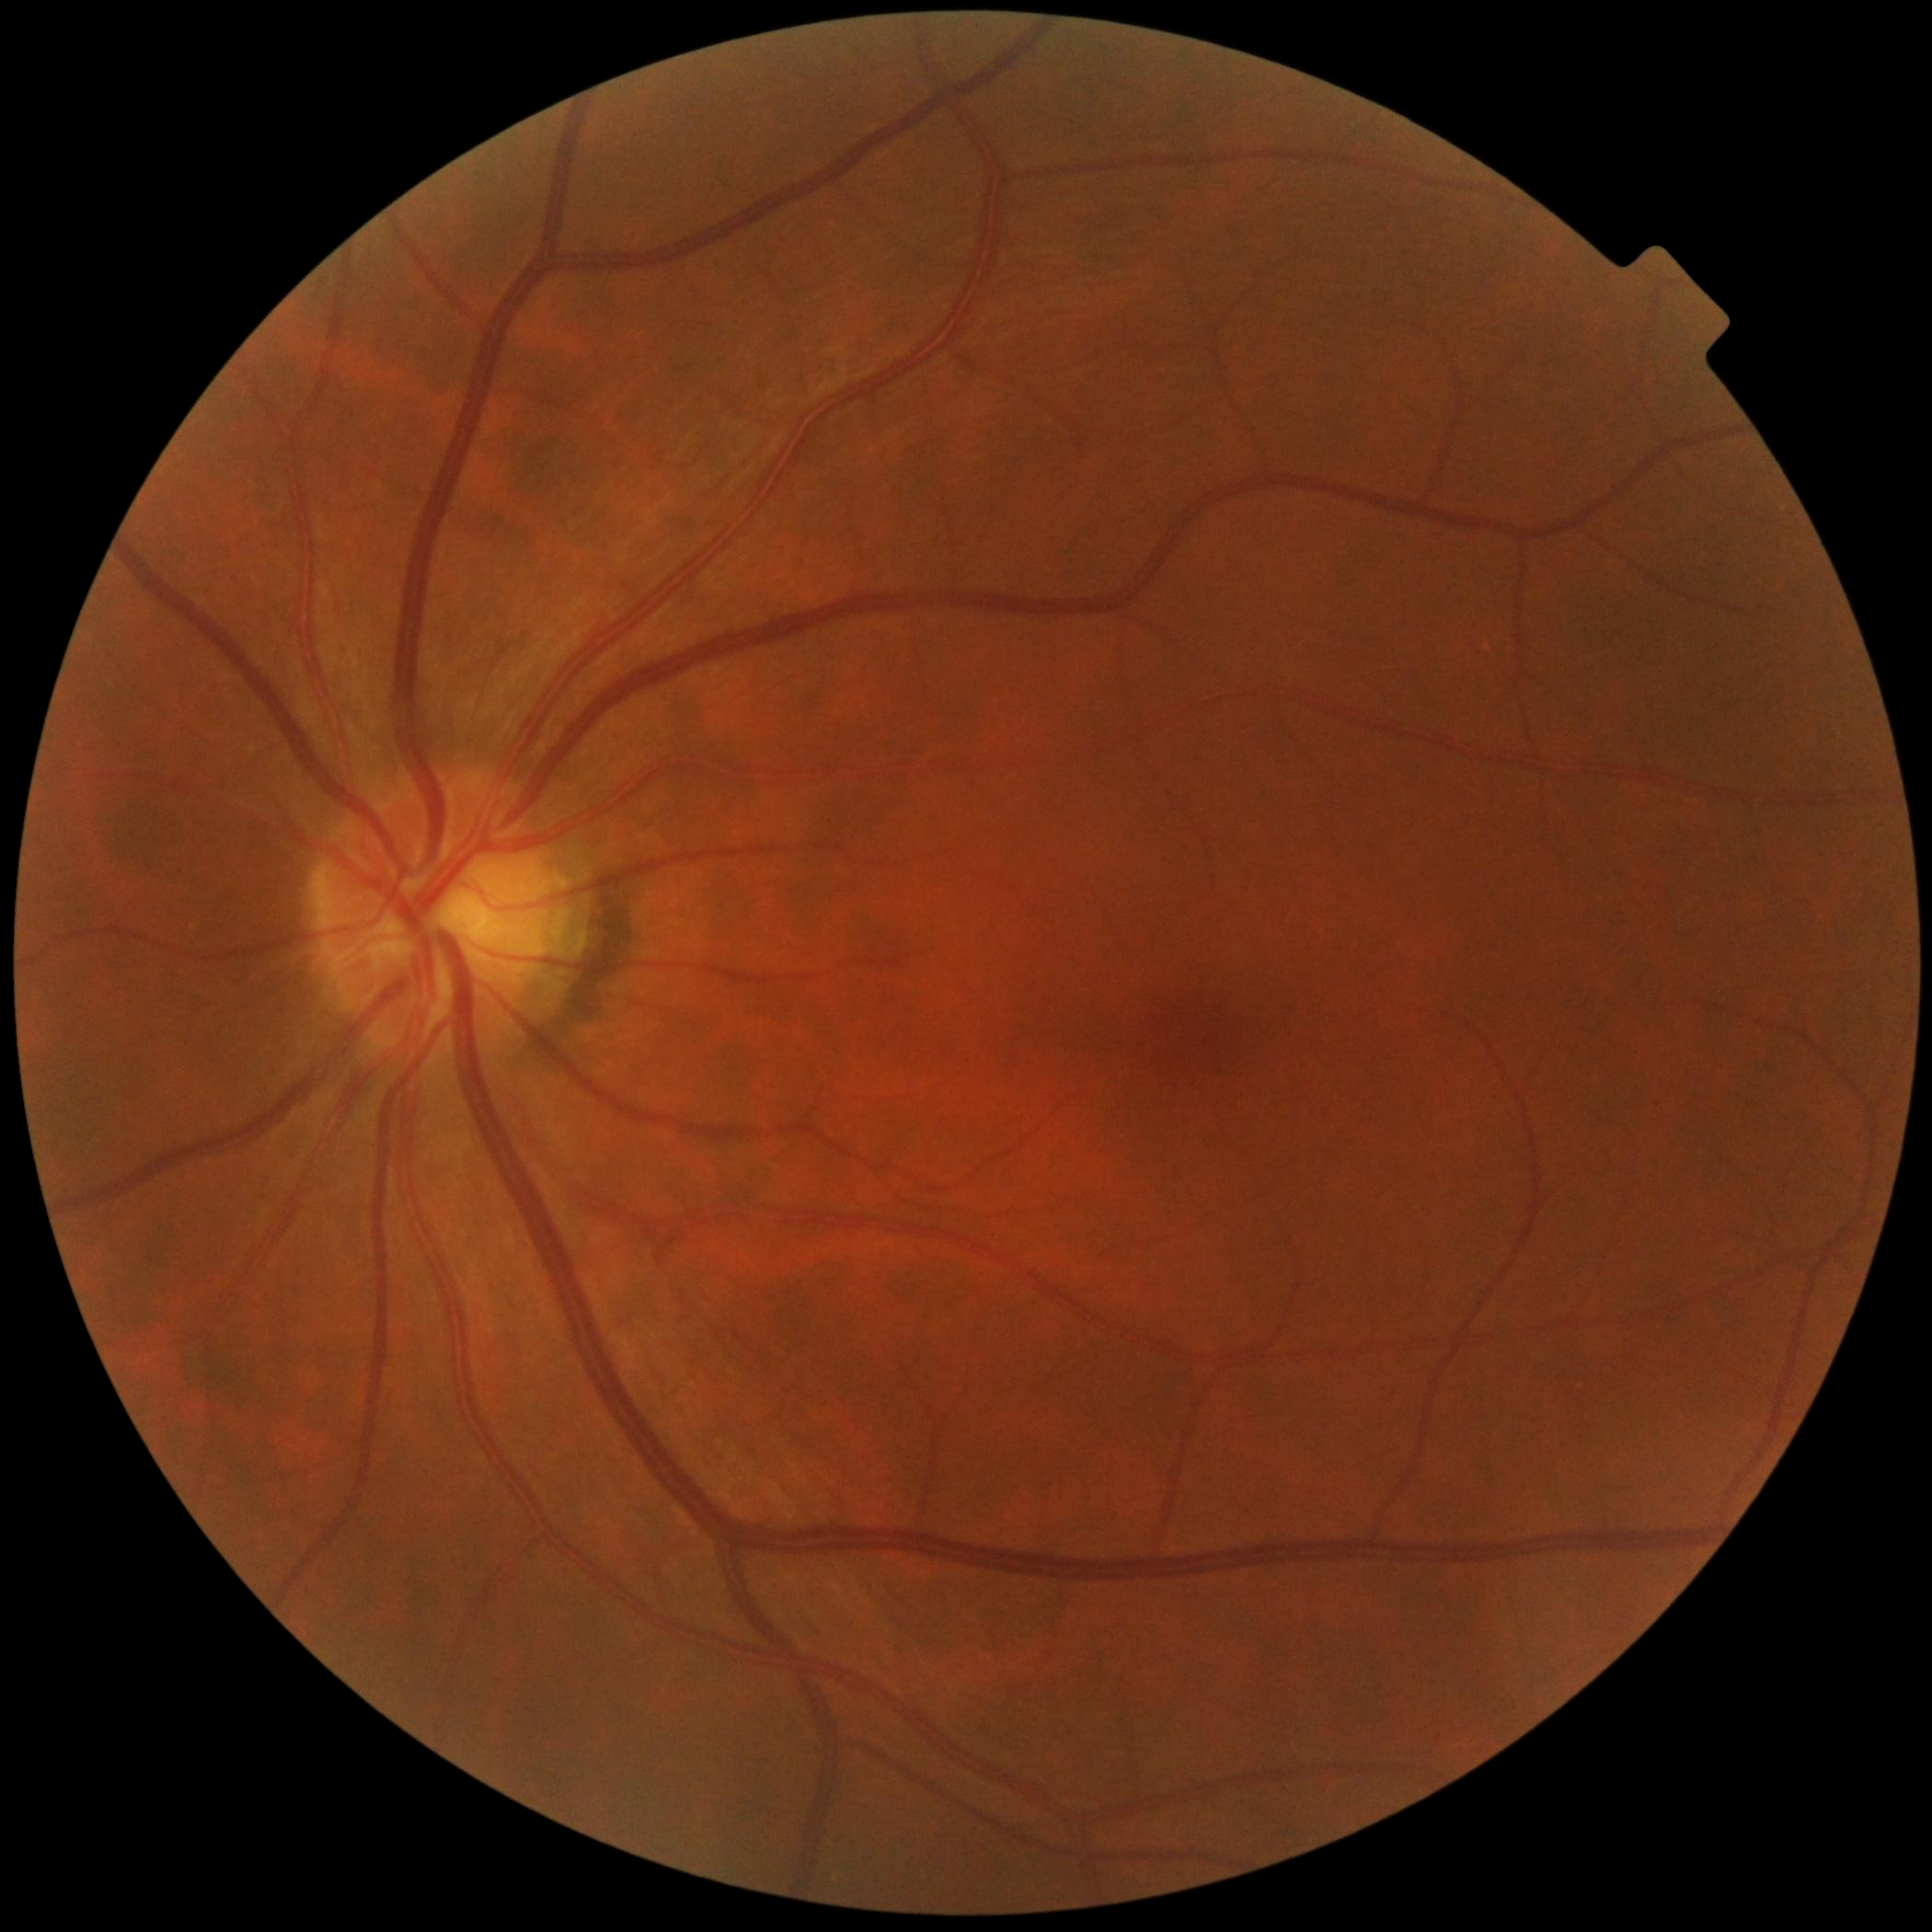
No apparent diabetic retinopathy.
DR severity is 0/4.